Wide-field fundus photograph from neonatal ROP screening
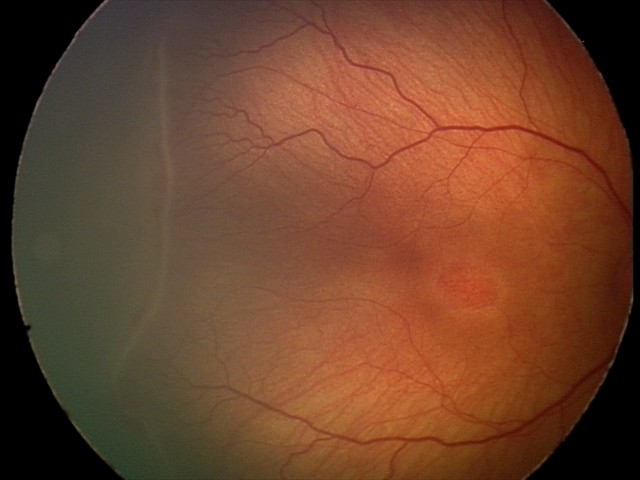 ROP stage: 2